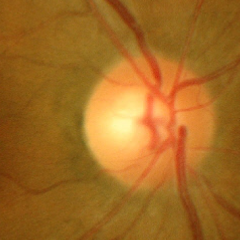
Diagnosis: no glaucomatous optic neuropathy.